Nonmydriatic fundus photograph
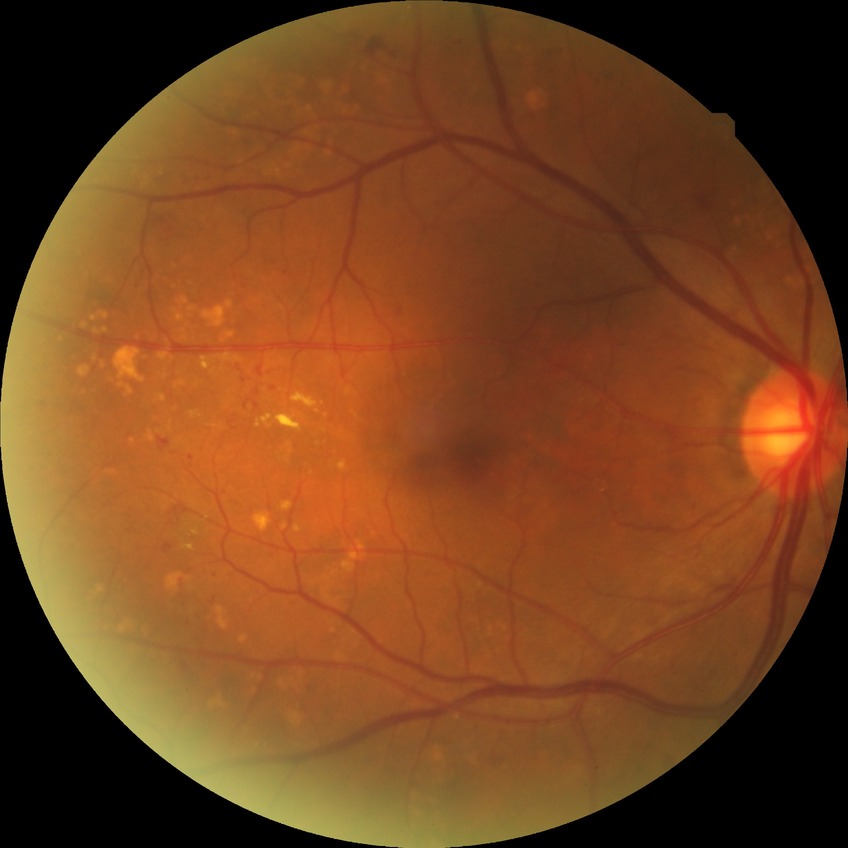
Davis DR grade is PPDR.